Modified Davis classification, NIDEK AFC-230
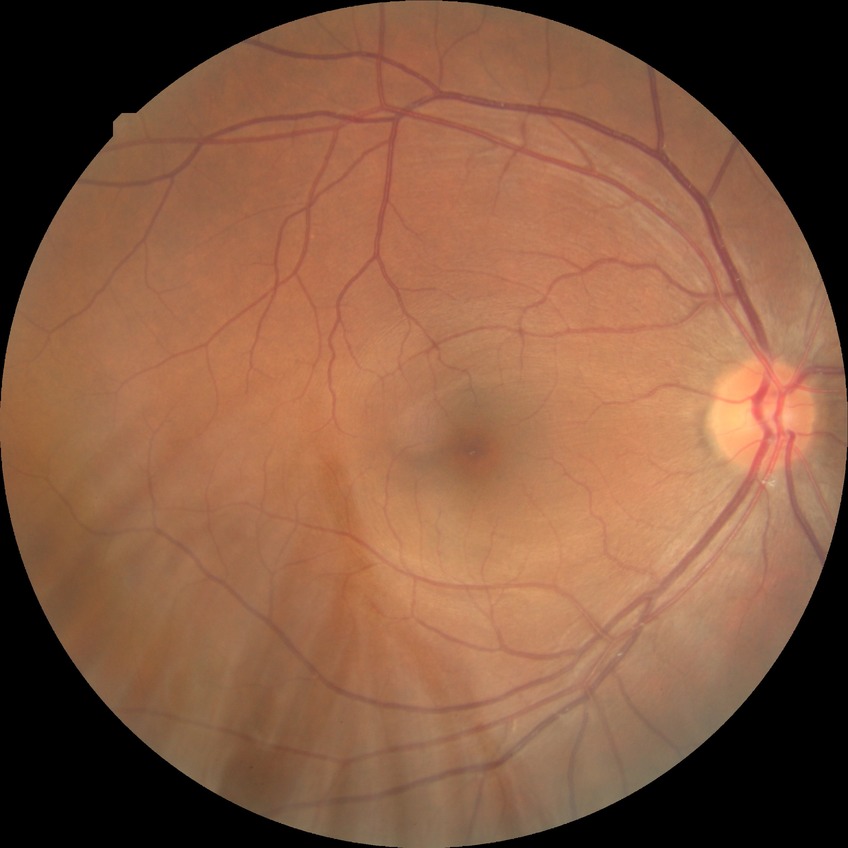

Findings:
* diabetic retinopathy (DR) — no diabetic retinopathy (NDR)